CFP, 2352 by 1568 pixels.
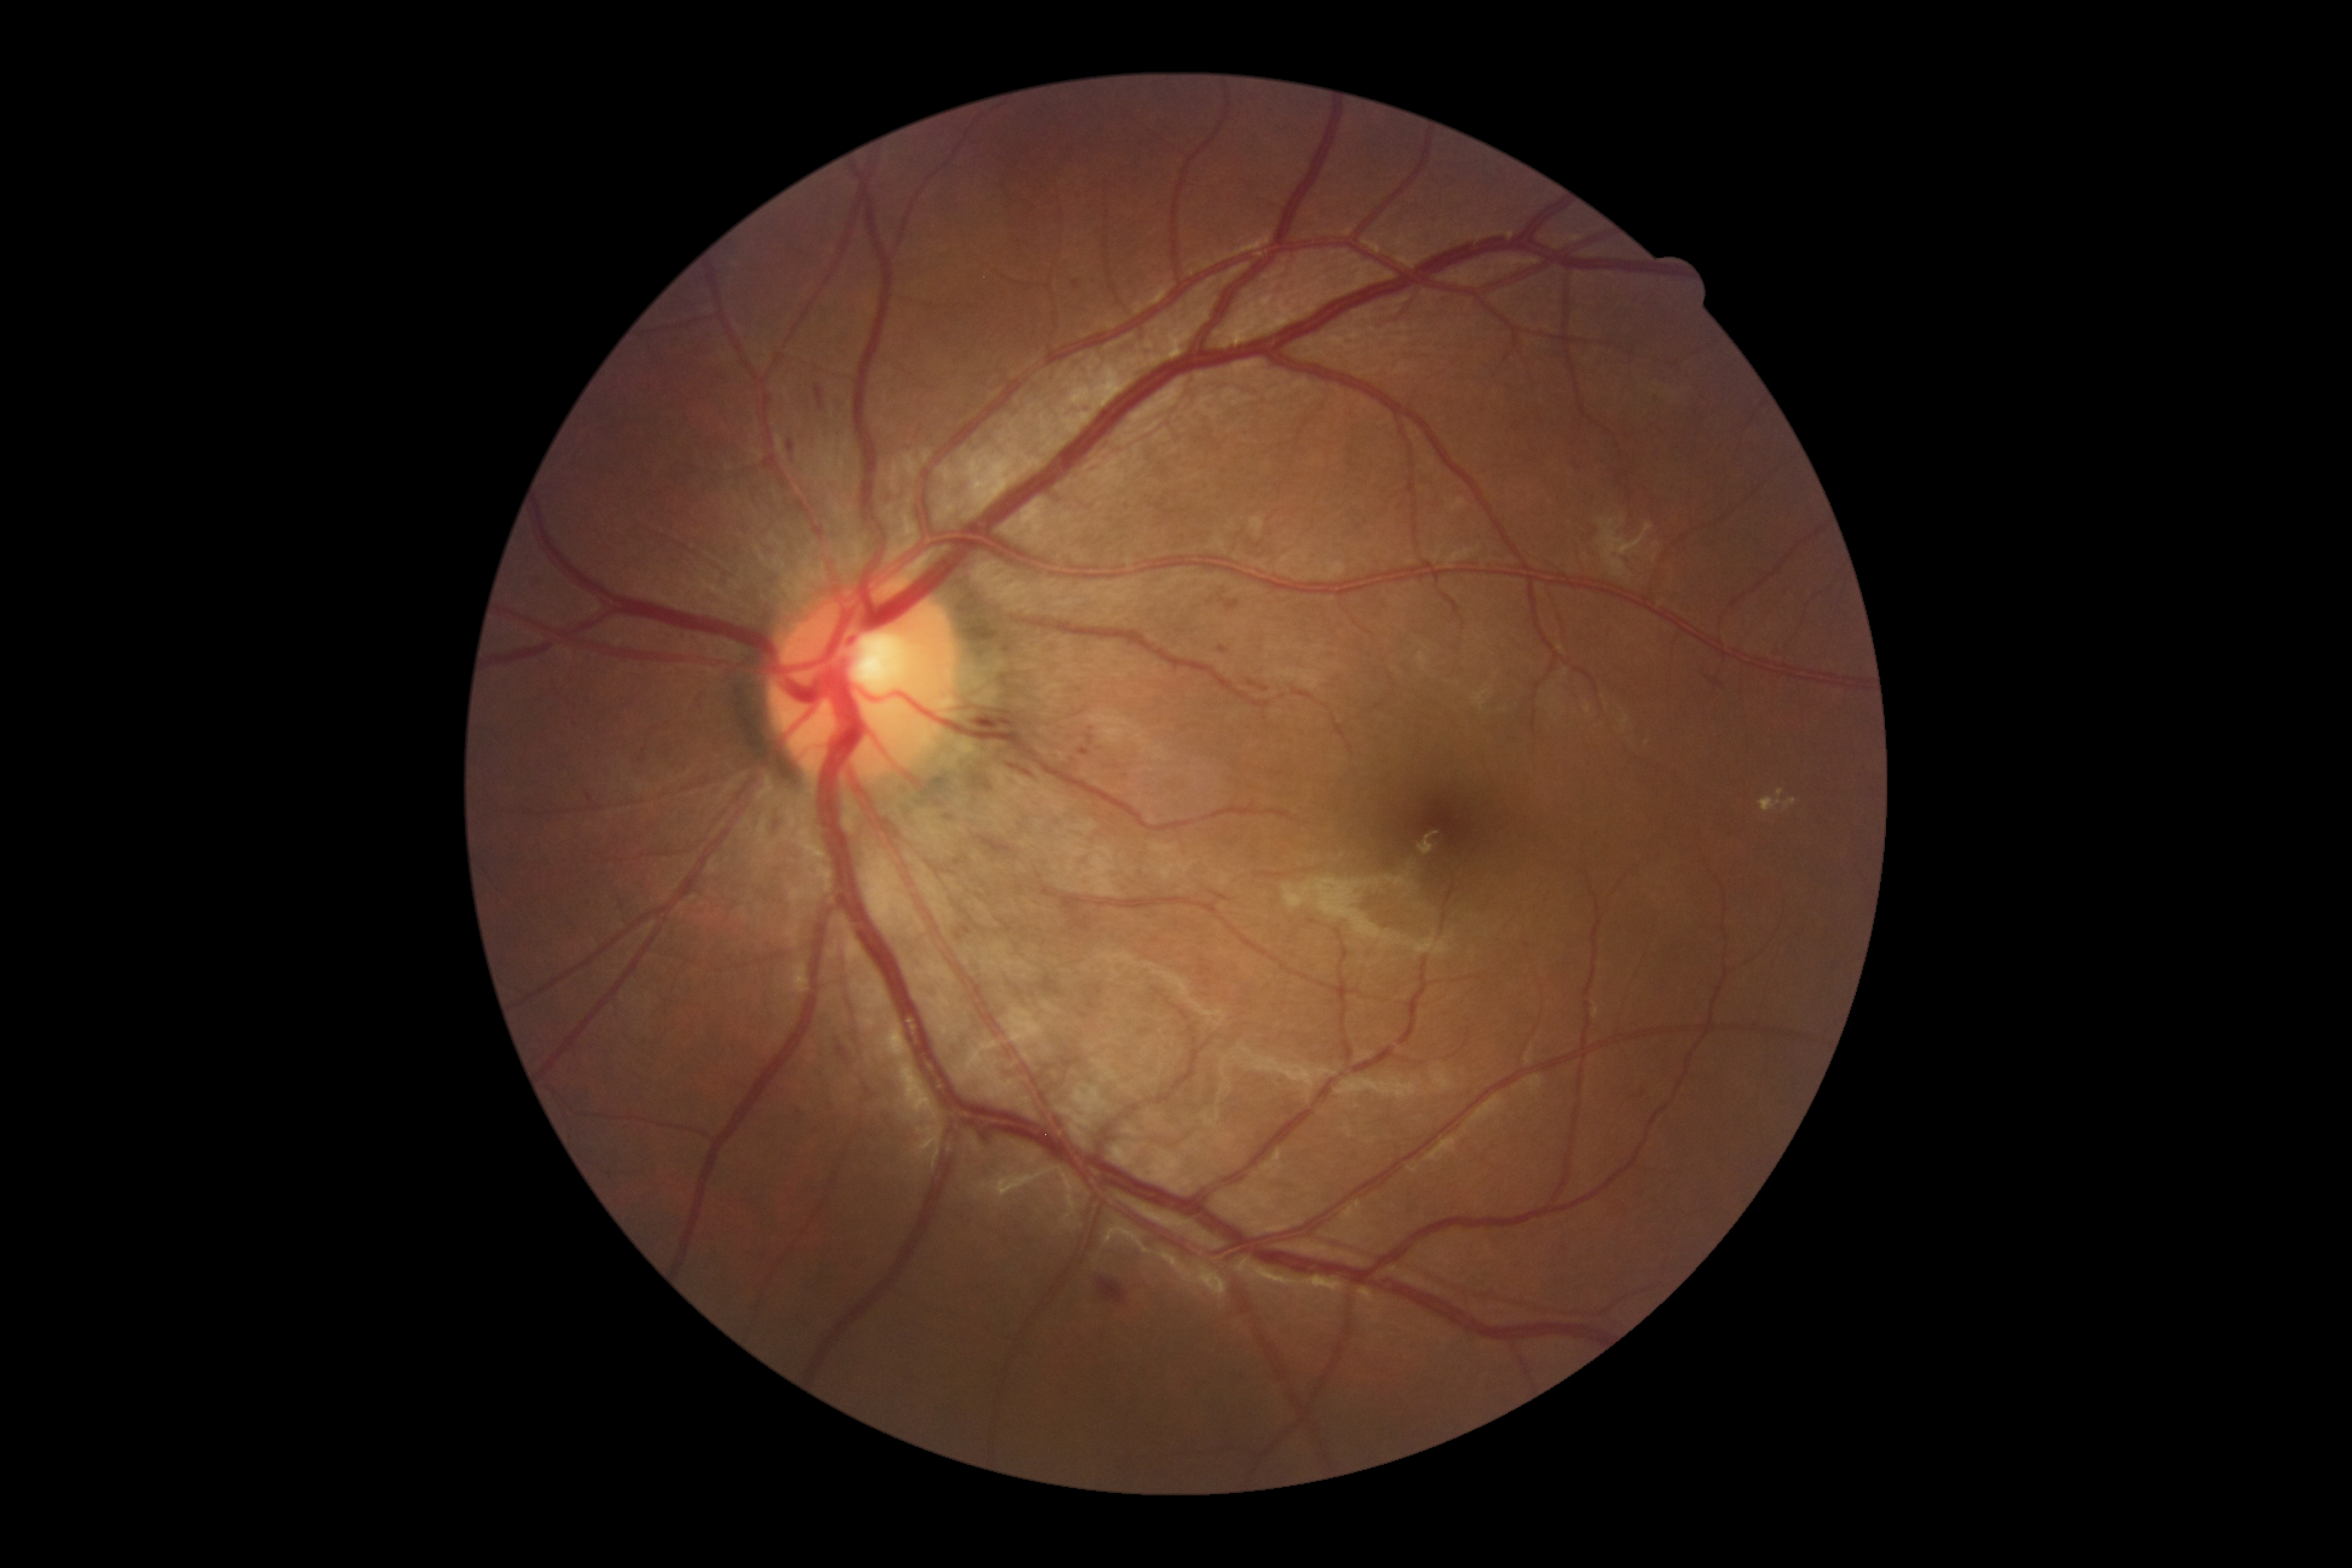
Diabetic retinopathy: 2; non-proliferative diabetic retinopathy.
Microaneurysms (partial list) at 1073,281,1080,289 | 639,750,645,762 | 1081,750,1089,756 | 1218,647,1229,654 | 1086,735,1094,745 | 587,795,593,804 | 961,927,971,936.
Hemorrhages (partial list) at 966,1125,989,1150 | 1040,976,1063,995 | 862,1082,875,1099 | 771,818,781,833 | 835,1039,852,1068 | 815,384,826,411 | 1062,896,1089,915 | 787,440,794,453 | 1219,598,1240,613 | 1007,764,1030,779 | 1071,916,1091,932 | 1098,1277,1128,1305 | 967,716,1014,728.
No soft exudates identified.
Hard exudates found at 1759,798,1797,814.